45° FOV. Retinal fundus photograph. 2352x1568px
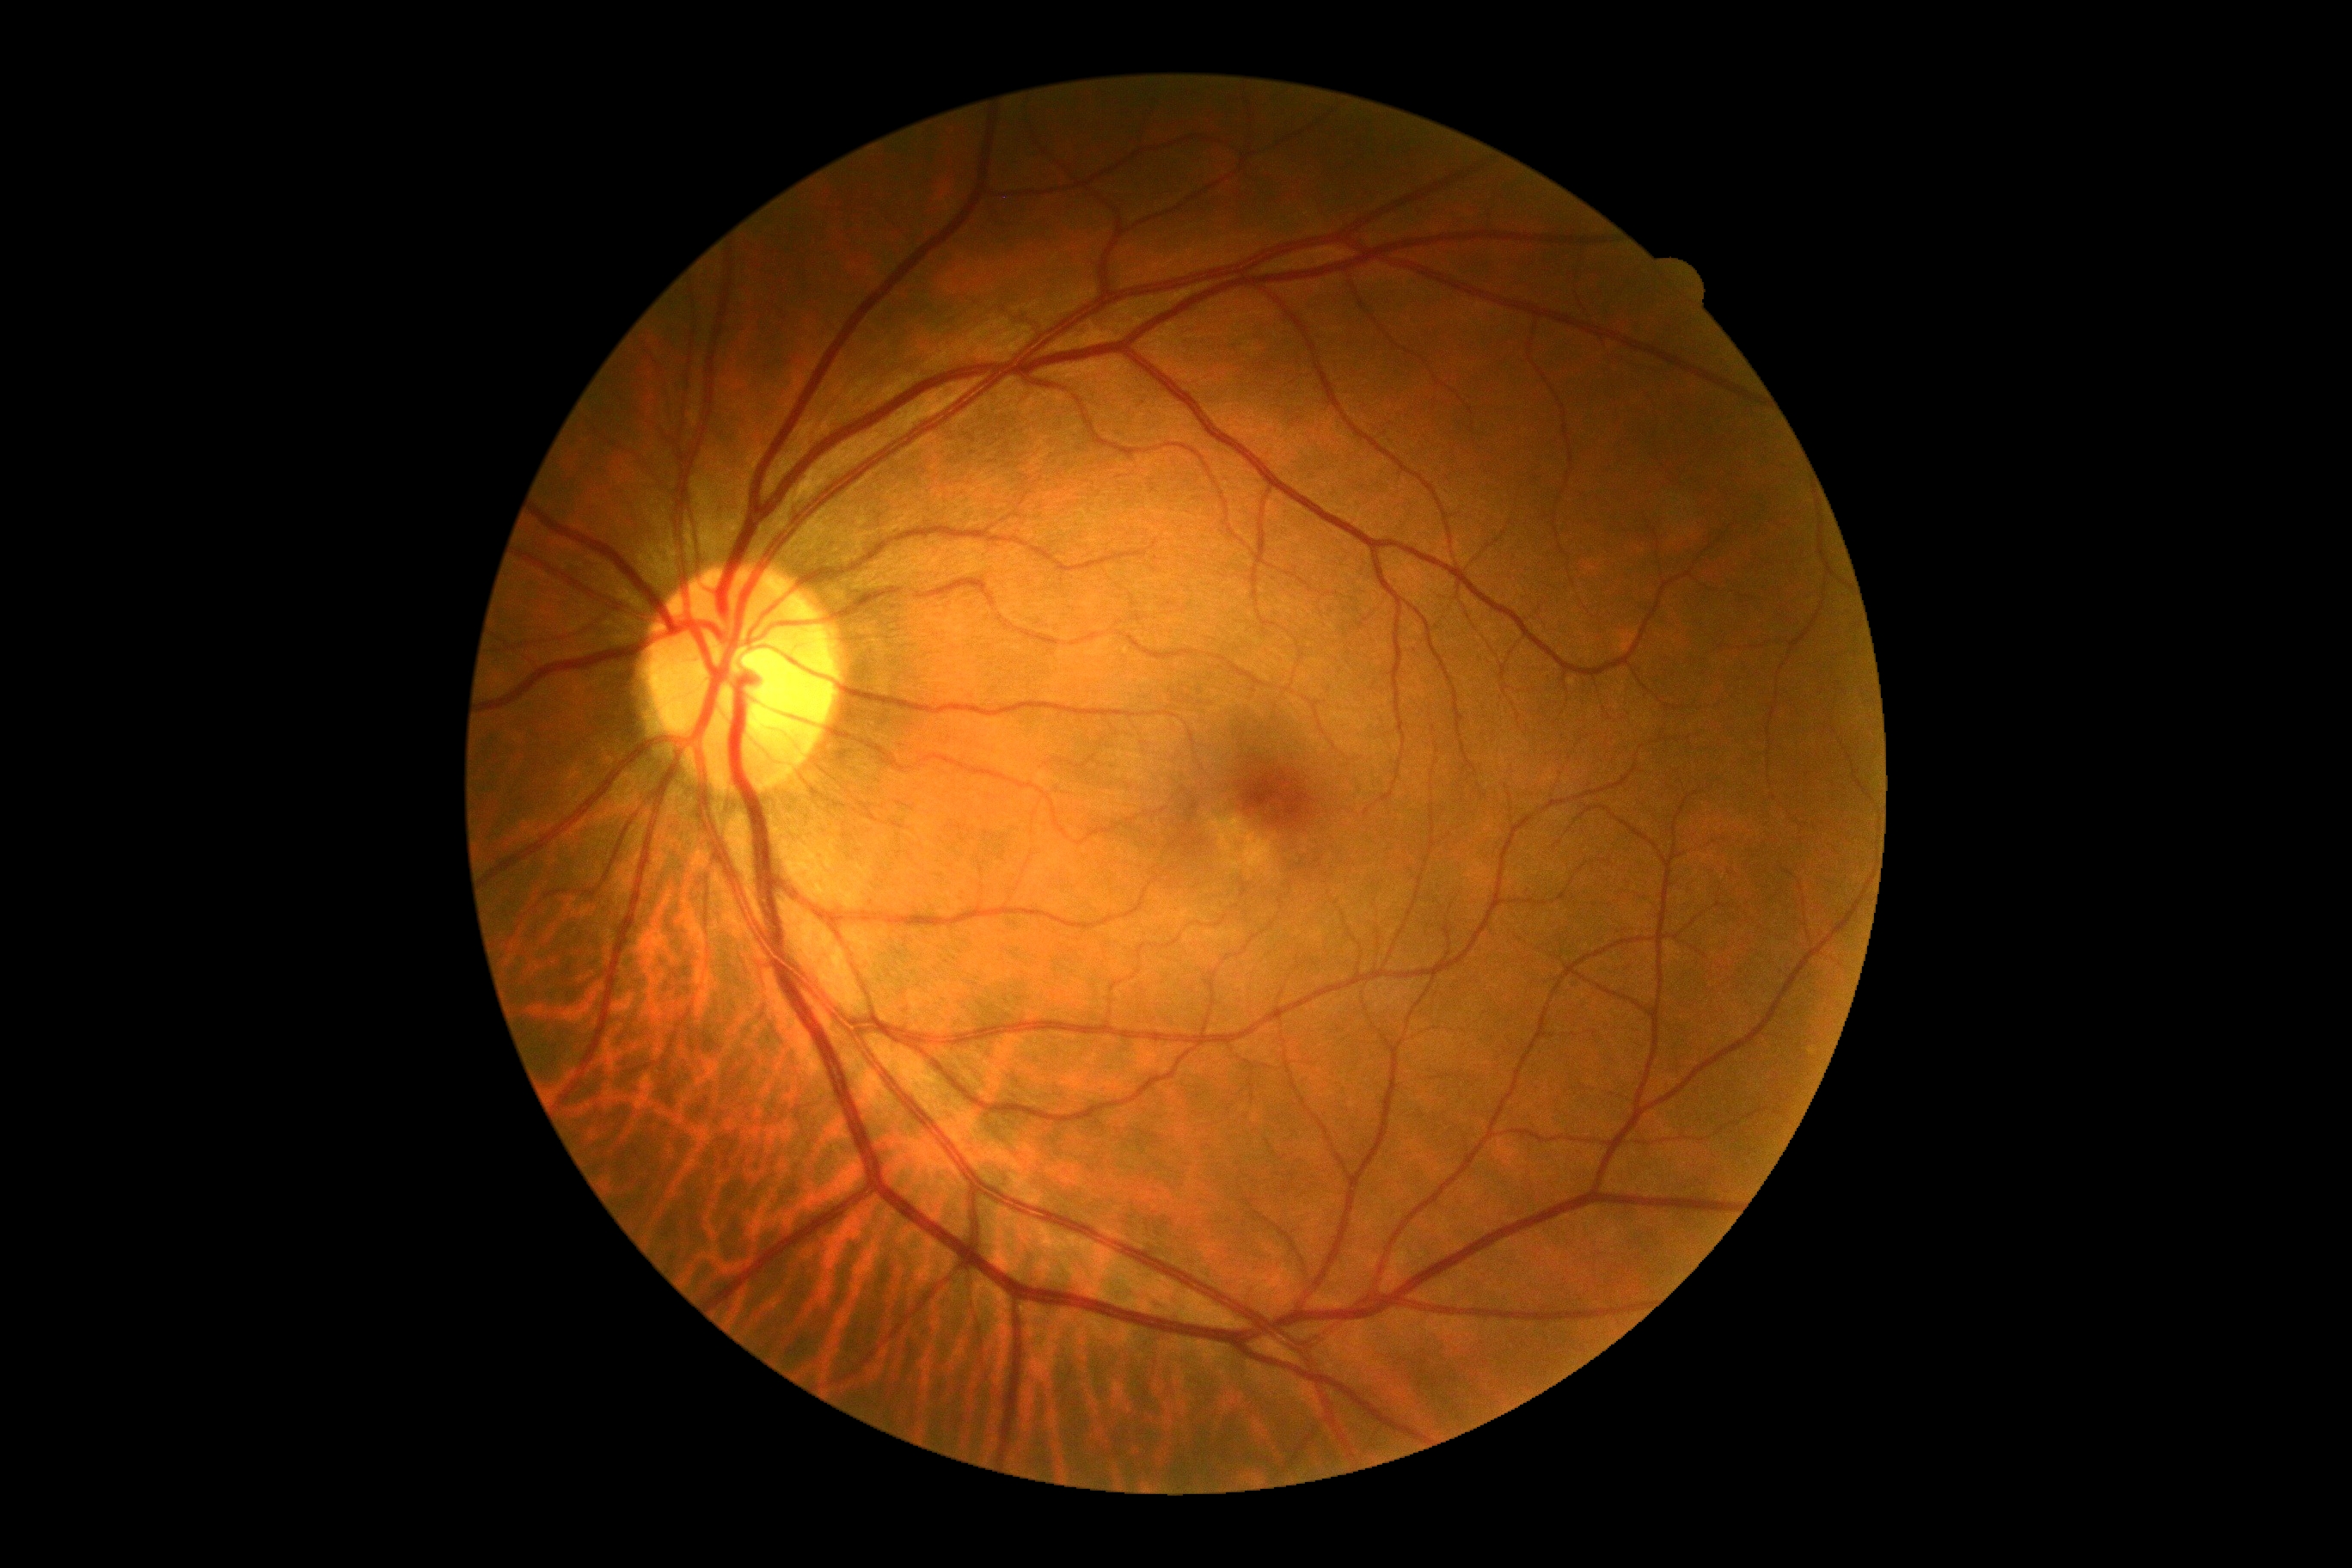 Diabetic retinopathy grade: 0 (no apparent retinopathy).